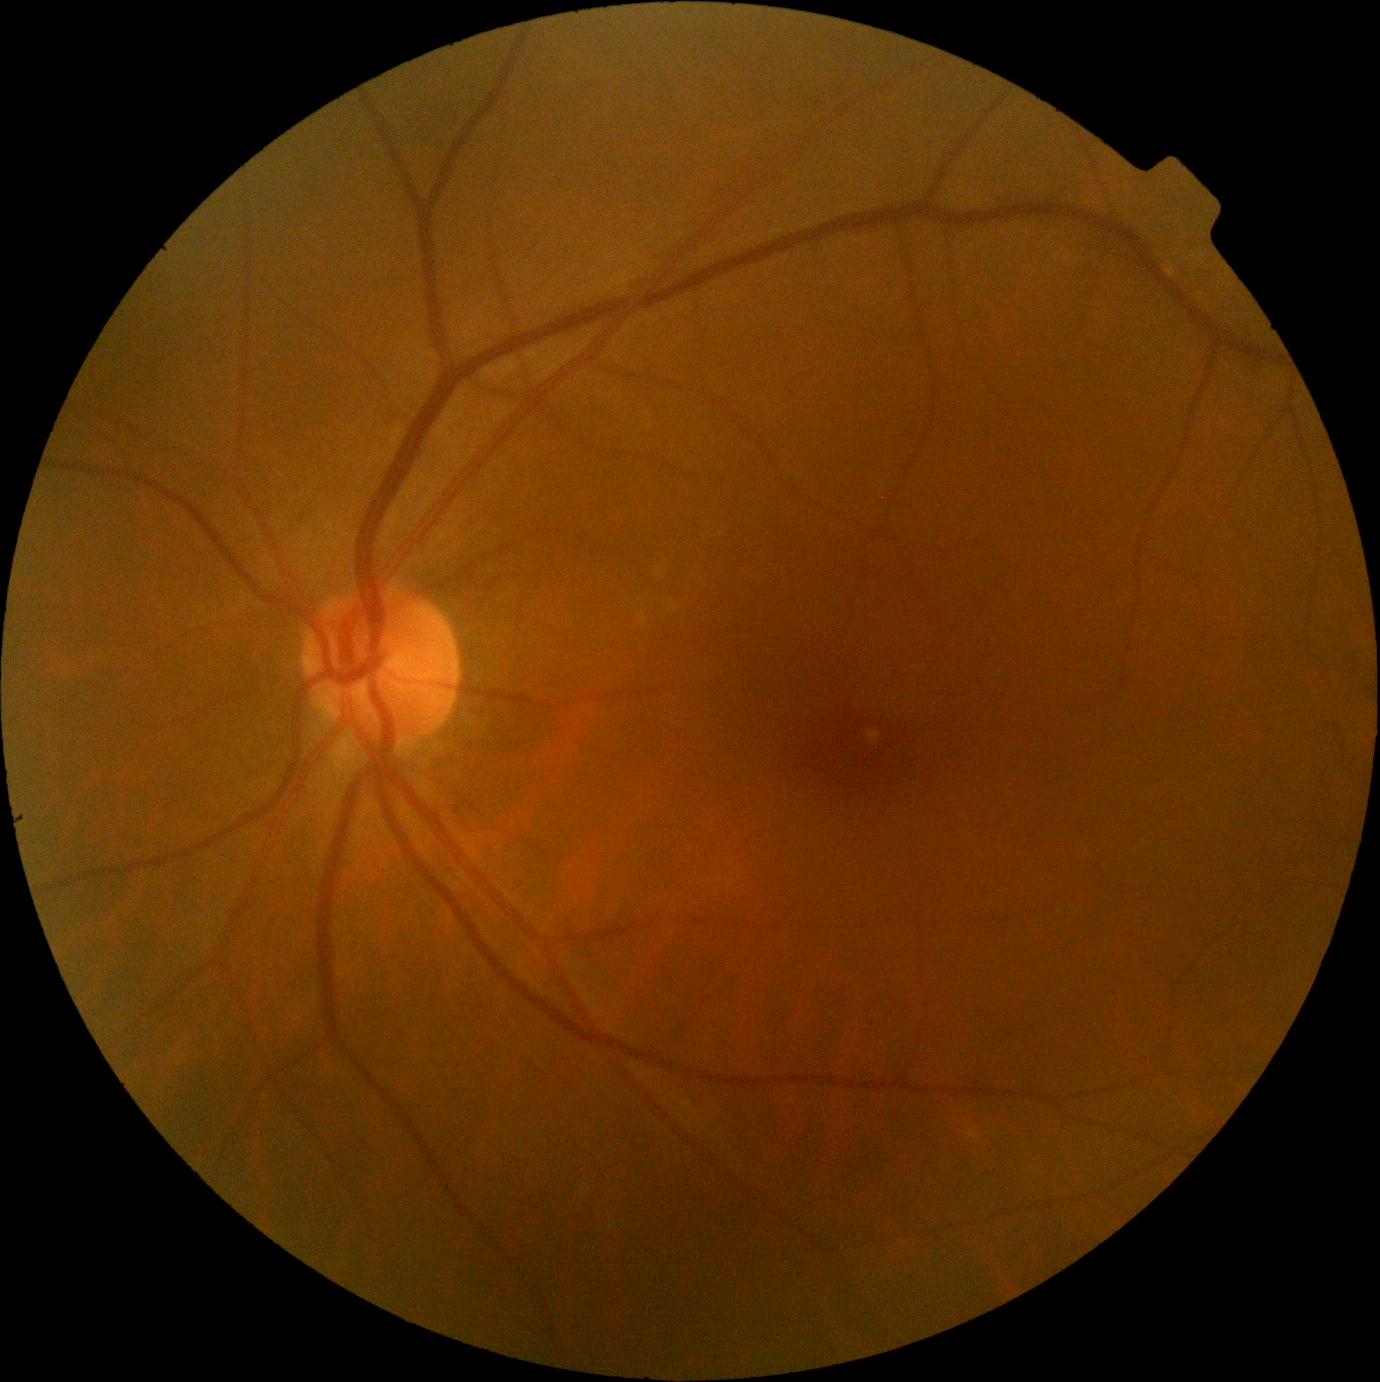
Diabetic retinopathy (DR) is no apparent diabetic retinopathy (grade 0).